Clarity RetCam 3, 130° FOV. Image size 640x480. RetCam wide-field infant fundus image — 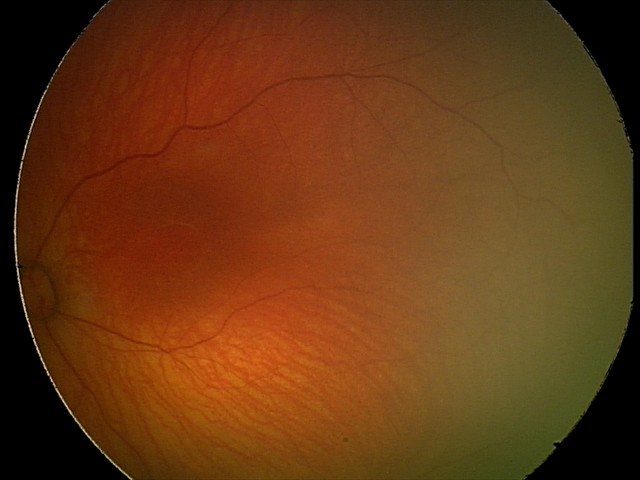 Impression: physiological retinal finding.